NIDEK AFC-230 fundus camera; 45° field of view
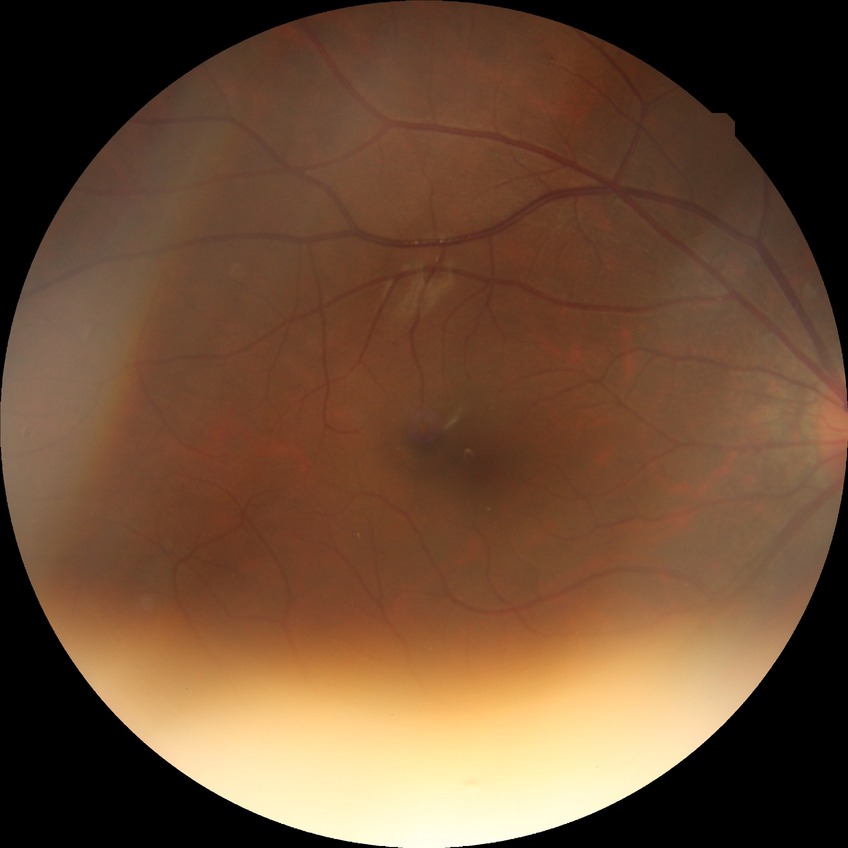 Assessment:
* Davis stage — NDR